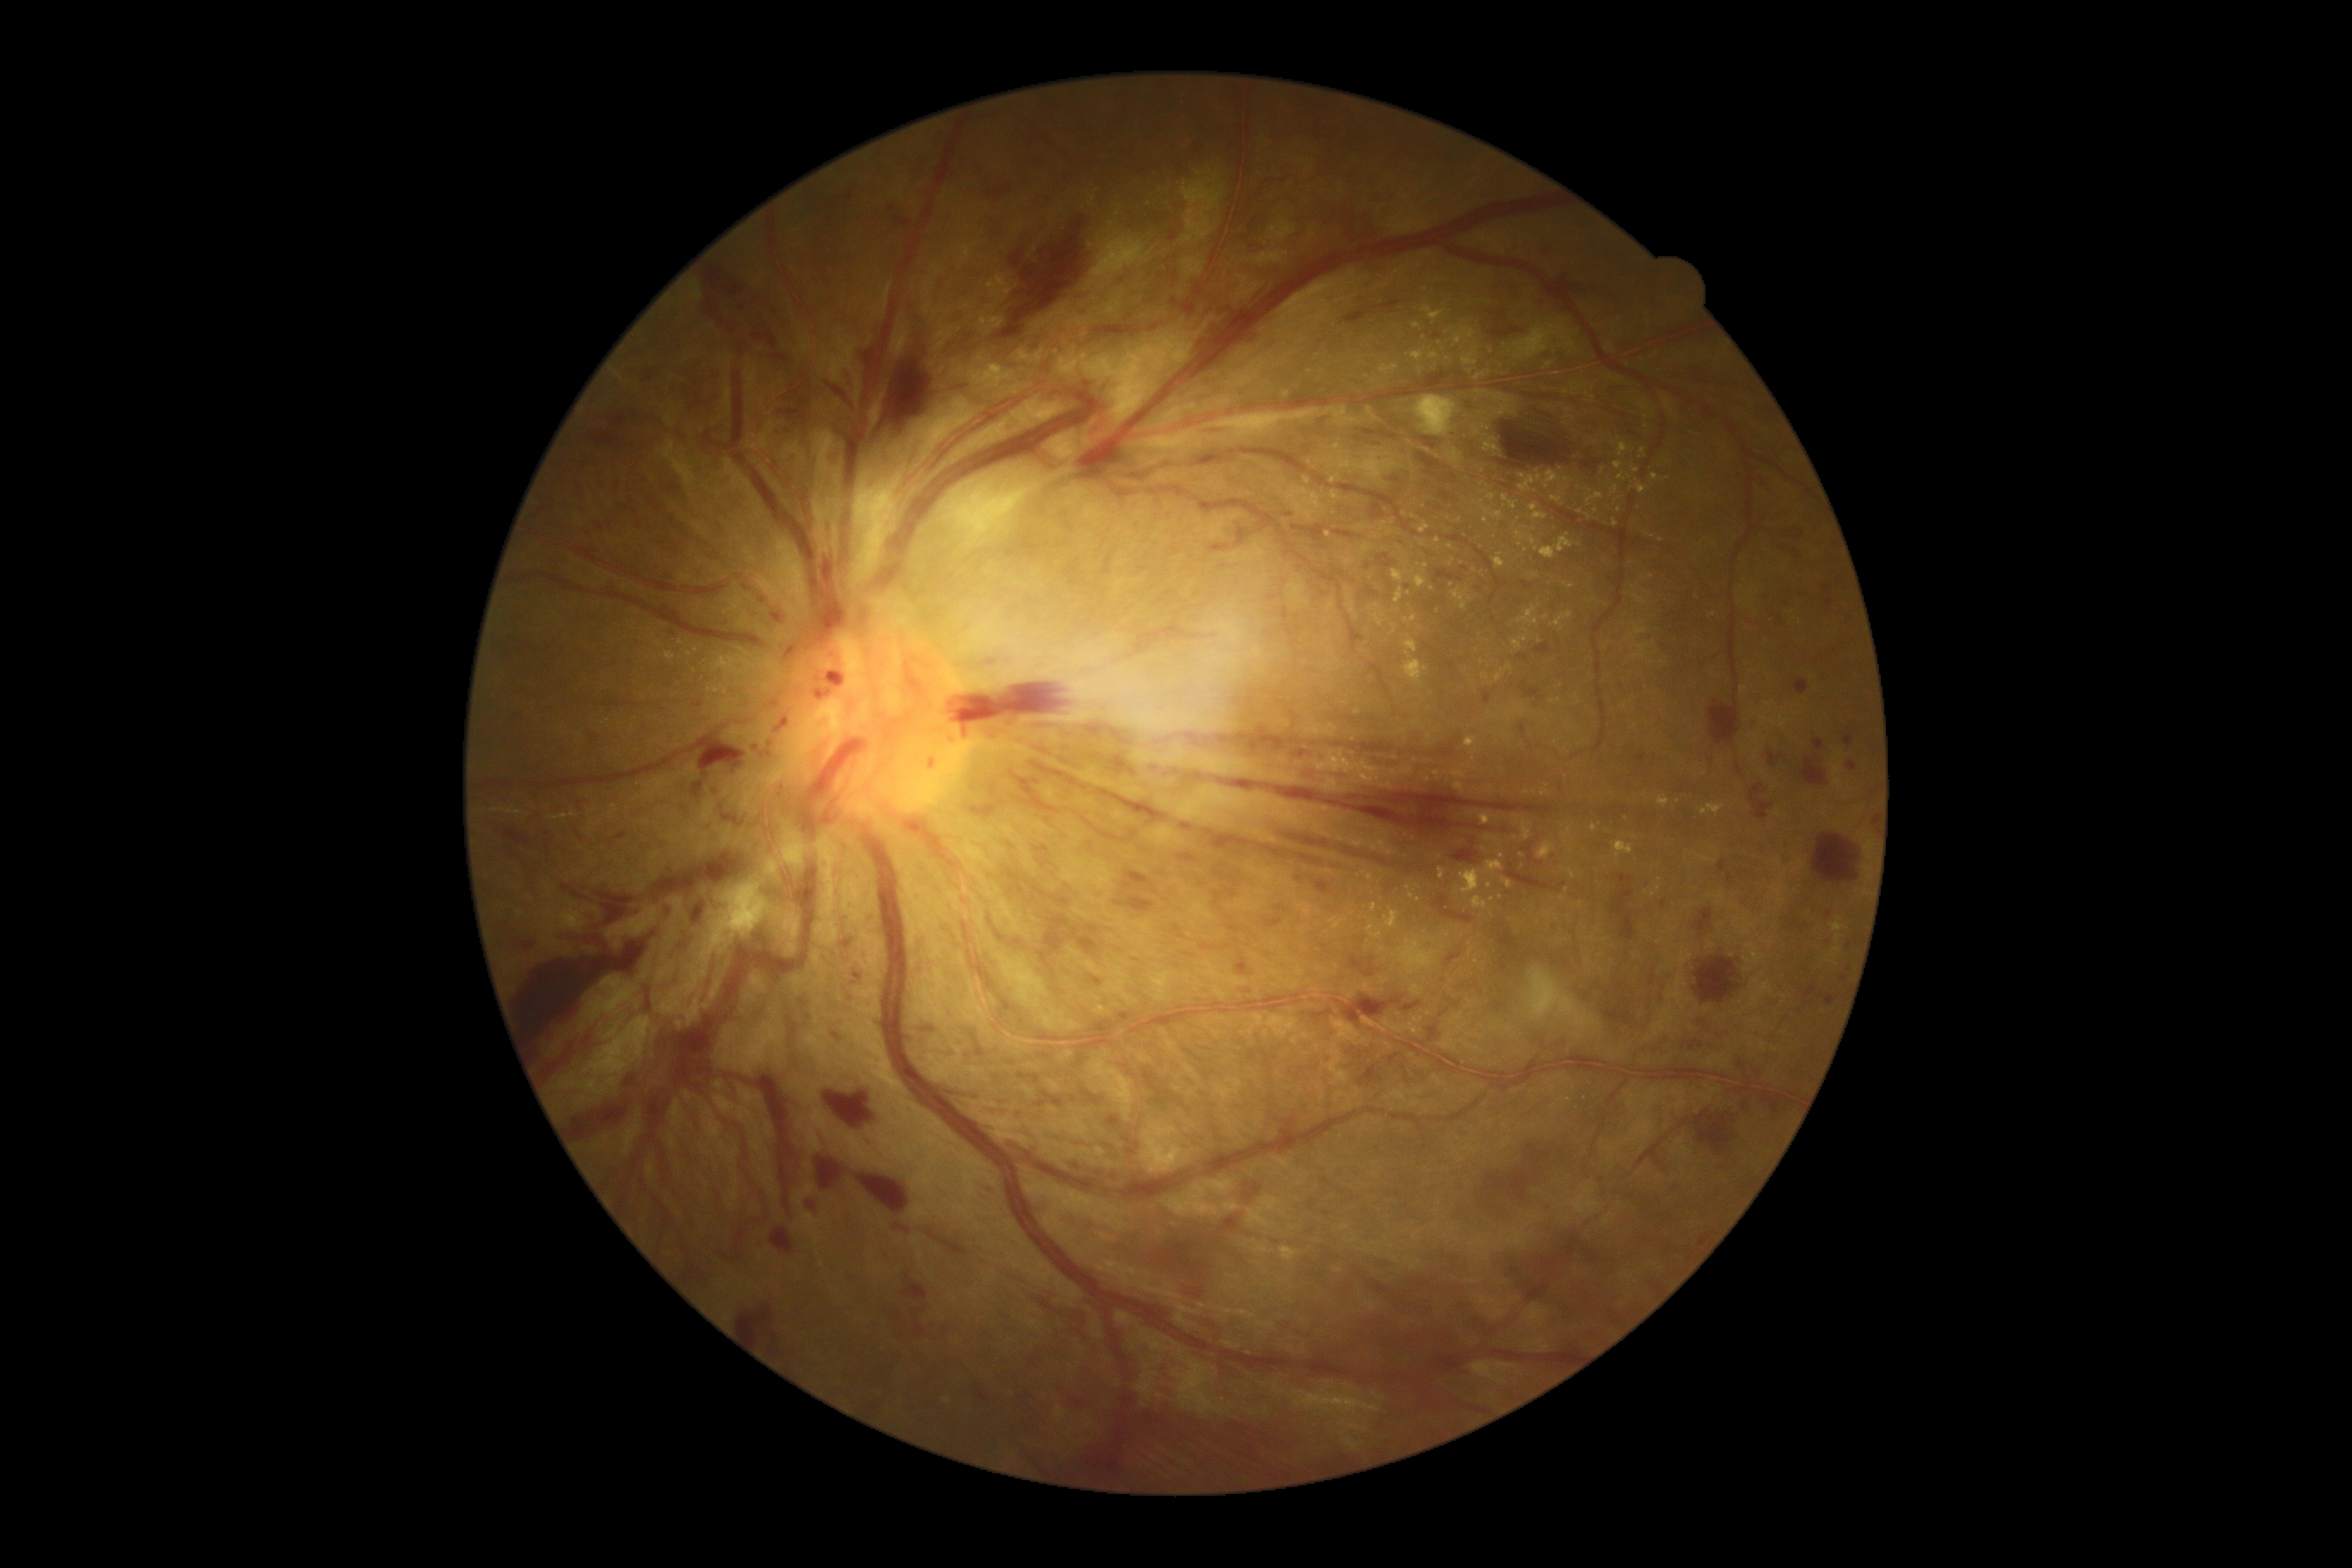 DR is 4/4.
EXs are present, including at (1404,616,1418,623); (1069,360,1077,367); (491,809,524,818); (1418,522,1431,534); (1485,835,1497,842); (1452,771,1467,780); (1617,474,1626,481); (1552,613,1572,634); (1189,405,1197,410); (716,879,769,936); (1560,479,1574,494).
Small EXs near <point>1647, 534</point>; <point>1486, 521</point>; <point>1371, 578</point>; <point>948, 1401</point>; <point>1662, 540</point>; <point>1493, 900</point>; <point>1287, 395</point>; <point>1546, 617</point>; <point>822, 1263</point>.
MAs are present, including at (854,972,861,981); (1822,585,1830,592); (1636,754,1646,763); (1827,597,1835,606); (1662,900,1667,909).
Small MAs near <point>1844, 979</point>; <point>1408, 588</point>; <point>1531, 859</point>; <point>1849, 947</point>; <point>809, 1017</point>.
SEs found at (1526,967,1598,1032); (1414,396,1457,438).
HEs are present, including at (1282,833,1333,848); (1364,972,1373,977); (1507,866,1559,891); (1657,1038,1669,1046); (1767,1098,1779,1113); (1792,680,1808,695); (771,1228,793,1254); (1105,558,1113,575); (1490,407,1600,475); (1727,873,1737,885); (988,916,995,928); (1167,233,1177,240); (1029,761,1325,867); (1479,1172,1529,1211); (1760,848,1768,855); (986,187,1012,200); (1072,1158,1084,1175); (1369,503,1388,525); (830,444,842,467).
Small HEs near <point>932, 764</point>.